FOV 35° before cropping · ONH-centered crop from a color fundus image · 550 x 550 pixels — 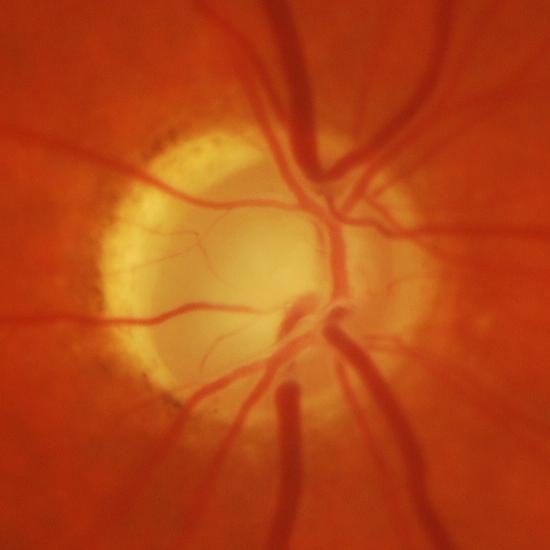 Evidence of glaucoma.